Color fundus photograph: 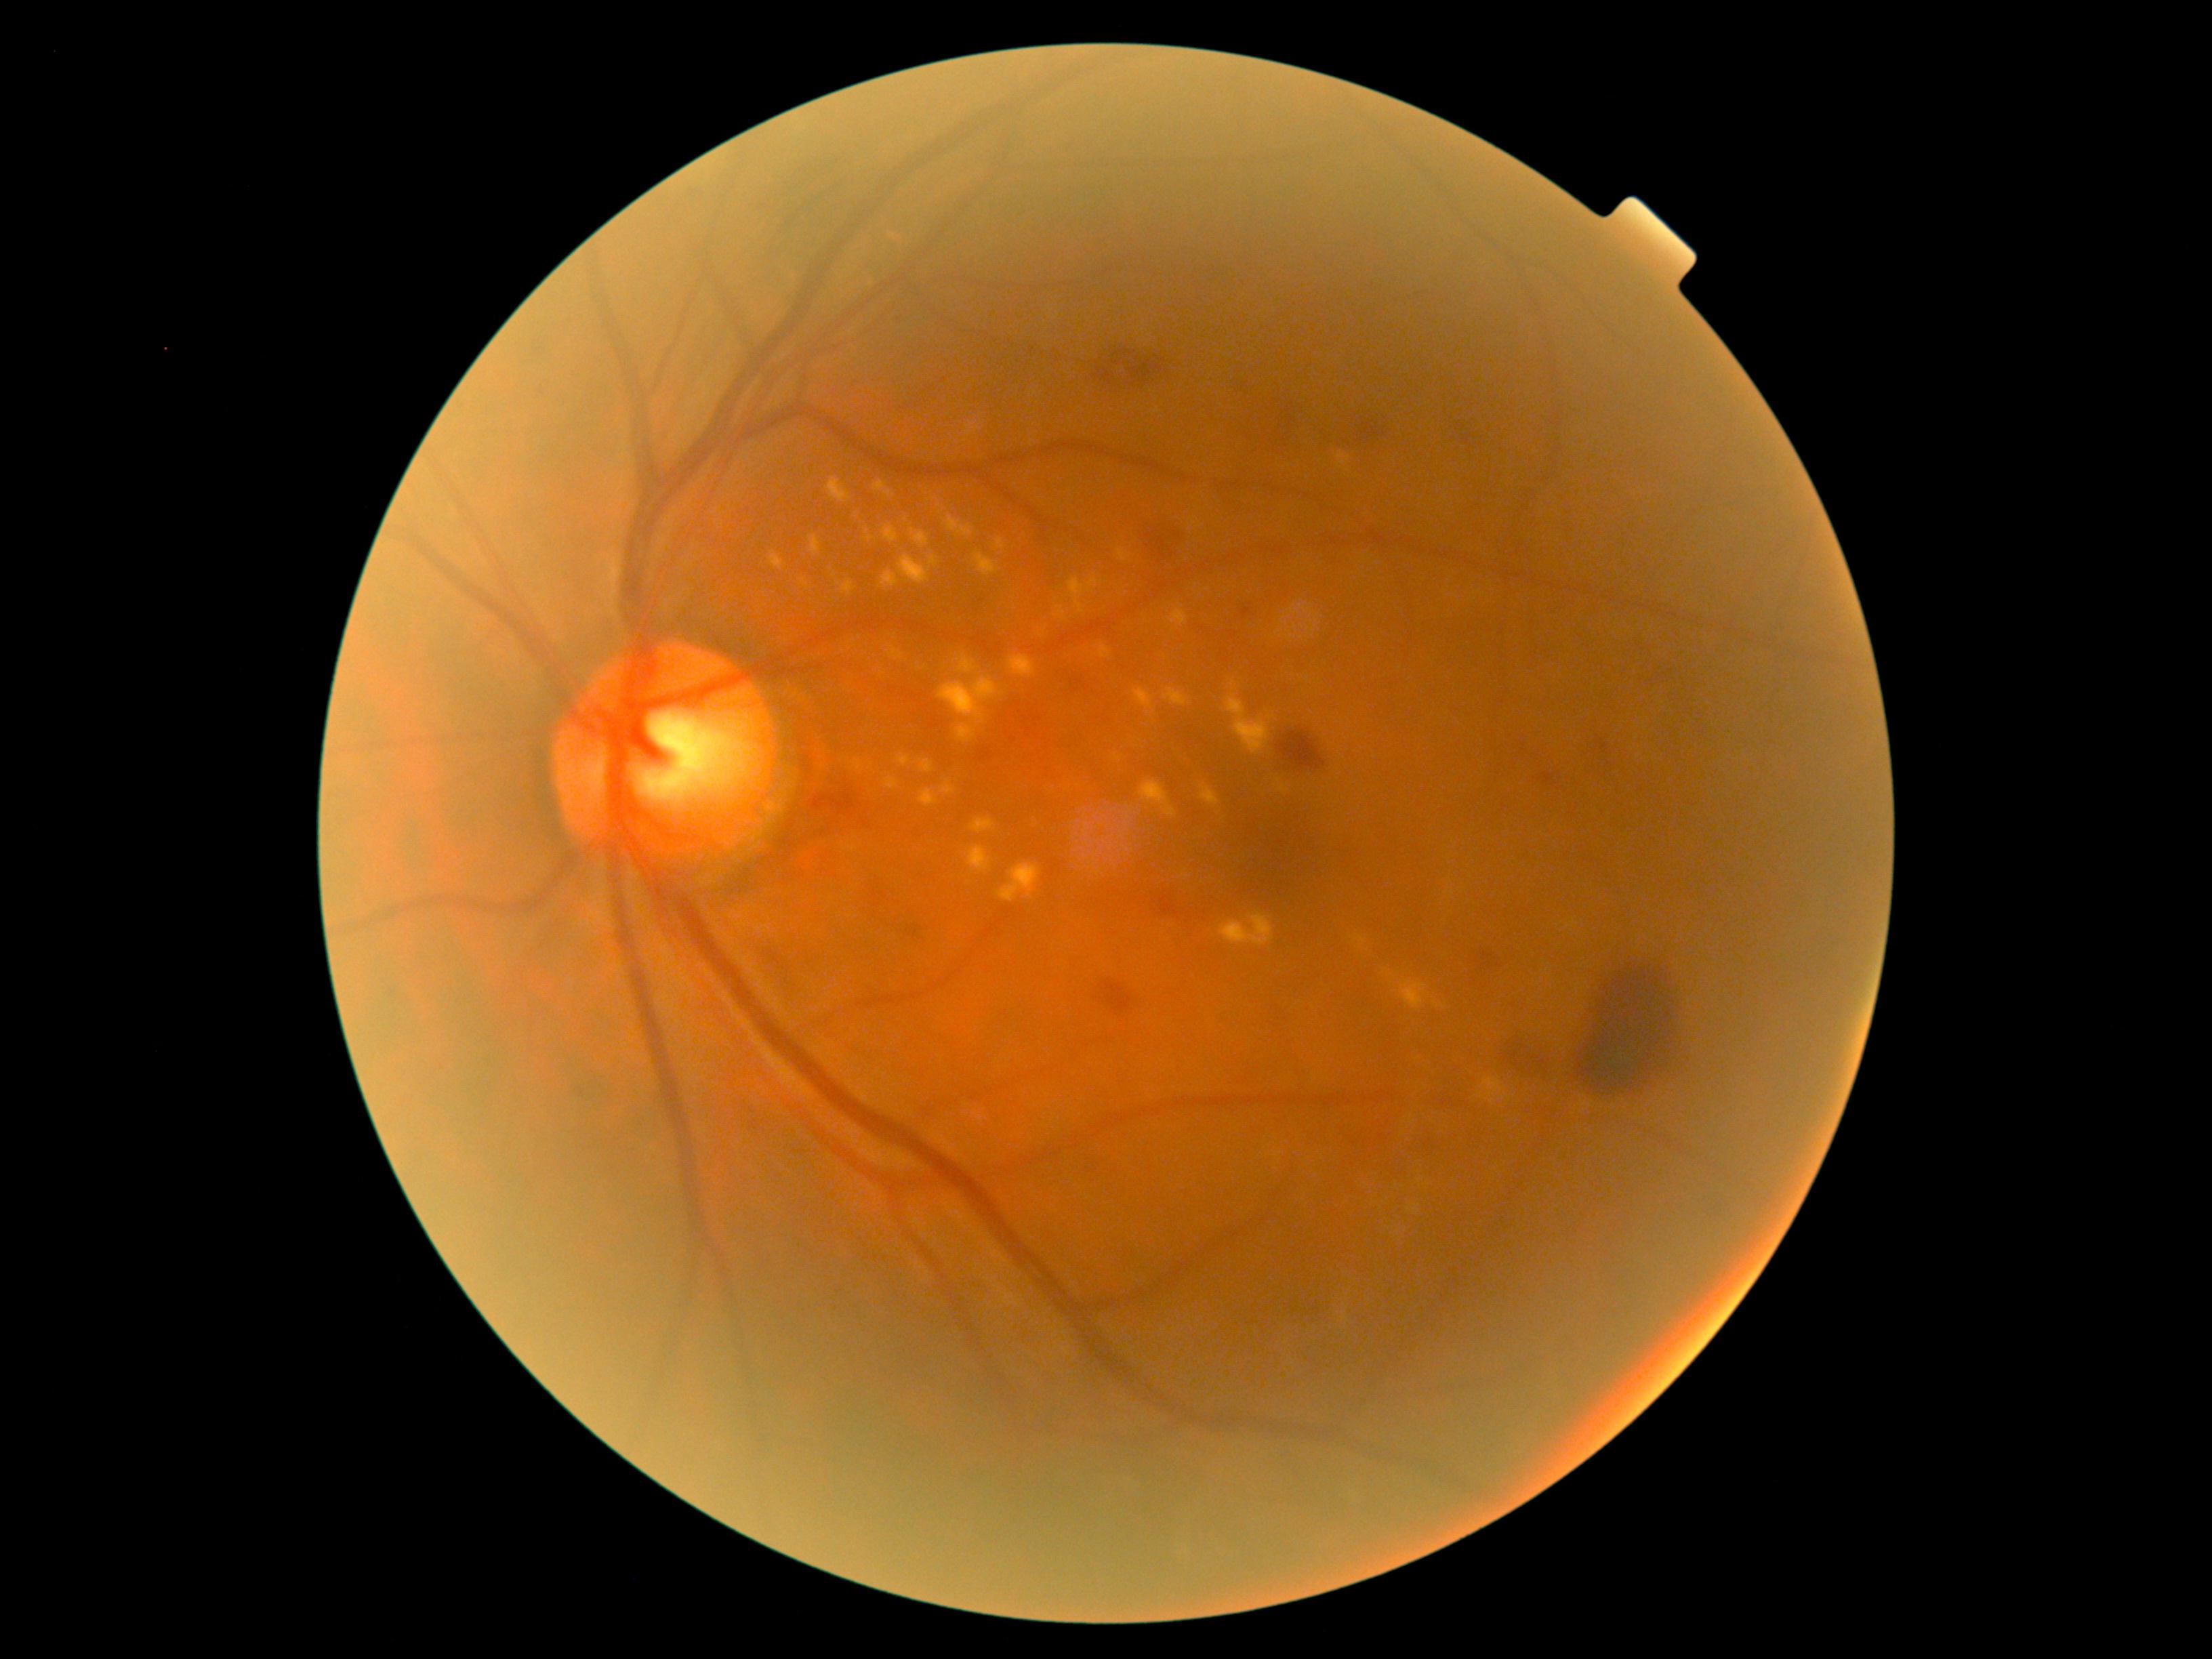 DR grade is 2 (moderate NPDR)
Selected lesions:
HEs: box=[1459, 428, 1473, 445]; box=[1516, 1032, 1561, 1077]; box=[1593, 737, 1608, 771]; box=[1070, 678, 1099, 701]; box=[1157, 521, 1196, 560]; box=[1241, 608, 1252, 617]; box=[1100, 979, 1132, 1013]; box=[1097, 344, 1176, 392]; box=[806, 788, 853, 815]; box=[1158, 890, 1180, 920]; box=[1576, 954, 1695, 1097]; box=[1542, 773, 1554, 784]; box=[907, 922, 921, 937]; box=[1348, 421, 1397, 445]; box=[1482, 945, 1501, 966]; box=[1277, 731, 1326, 771]; box=[1286, 411, 1300, 451]; box=[1088, 1154, 1104, 1172]; box=[1225, 377, 1252, 388]
SEs: not present
MAs: not present
EXs (subset): box=[909, 546, 933, 578]; box=[888, 232, 898, 241]; box=[1200, 785, 1221, 806]; box=[807, 535, 822, 560]; box=[998, 864, 1042, 903]; box=[1337, 452, 1351, 468]; box=[796, 573, 811, 589]; box=[945, 517, 974, 539]; box=[872, 563, 899, 583]; box=[932, 685, 970, 714]; box=[914, 523, 930, 543]; box=[830, 471, 848, 498]; box=[1277, 780, 1290, 794]; box=[1356, 937, 1368, 948]; box=[1226, 695, 1273, 754]
Smaller EXs around x=1235 y=689